Color fundus image · 2352x1568 — 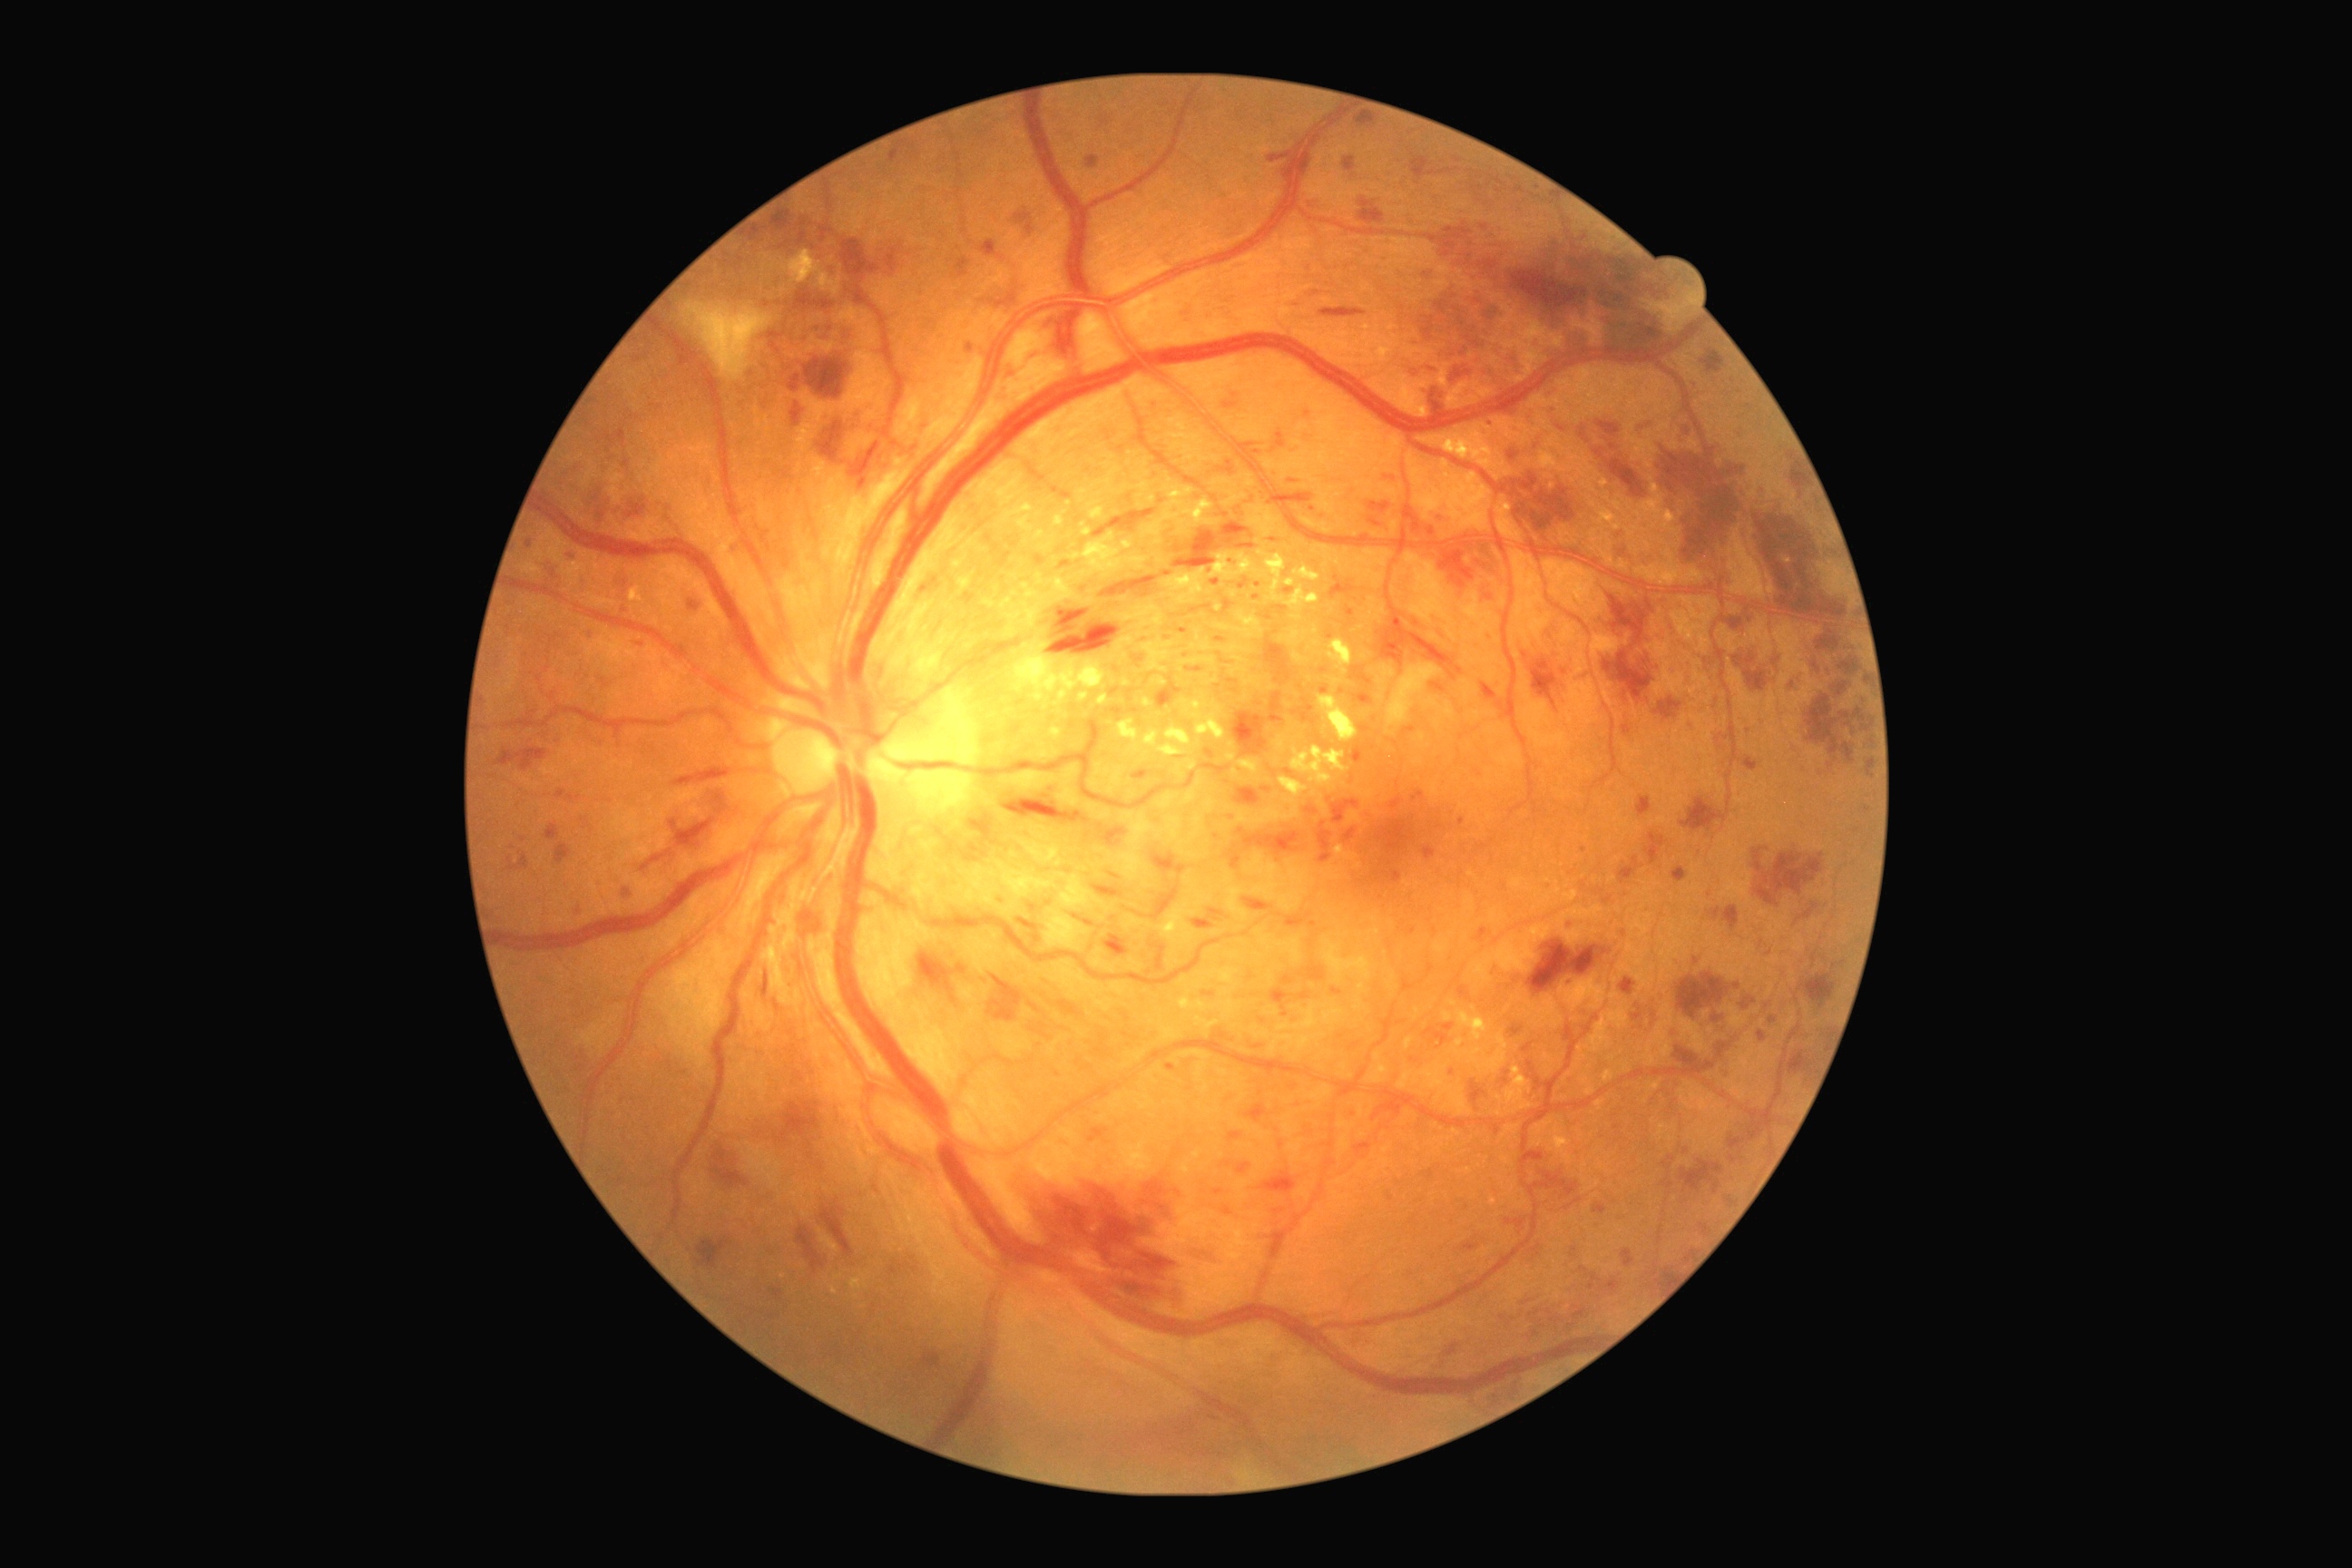

partial: true
dr_grade: 3
dr_grade_name: severe NPDR
lesions:
  ex:
    - x1=1632 y1=476 x2=1683 y2=542
    - x1=1284 y1=585 x2=1320 y2=612
    - x1=1277 y1=736 x2=1284 y2=749
    - x1=1003 y1=502 x2=1034 y2=524
    - x1=1318 y1=801 x2=1328 y2=818
    - x1=1233 y1=656 x2=1250 y2=663
    - x1=1237 y1=1469 x2=1260 y2=1480
    - x1=1122 y1=542 x2=1133 y2=549
    - x1=1164 y1=569 x2=1206 y2=605
    - x1=1208 y1=678 x2=1217 y2=685
    - x1=1415 y1=471 x2=1493 y2=531
    - x1=1237 y1=760 x2=1260 y2=778
  ex_small_approx:
    - [x=1500, y=455]
    - [x=1015, y=594]
    - [x=1070, y=504]
    - [x=1138, y=748]
    - [x=1267, y=703]
  ma:
    - x1=774 y1=1001 x2=779 y2=1012
    - x1=1511 y1=1024 x2=1524 y2=1039
    - x1=1244 y1=1104 x2=1268 y2=1124
    - x1=1112 y1=707 x2=1122 y2=716
    - x1=1030 y1=1004 x2=1039 y2=1012
    - x1=1422 y1=847 x2=1436 y2=861
    - x1=808 y1=1153 x2=814 y2=1161
    - x1=1161 y1=257 x2=1170 y2=270
    - x1=1095 y1=1034 x2=1106 y2=1057
    - x1=1202 y1=992 x2=1217 y2=997
    - x1=689 y1=602 x2=698 y2=611
    - x1=1035 y1=554 x2=1046 y2=567
    - x1=1422 y1=1166 x2=1442 y2=1182
  ma_small_approx:
    - [x=1605, y=953]
    - [x=1622, y=553]
    - [x=1749, y=407]
    - [x=624, y=611]
    - [x=1155, y=408]
    - [x=1561, y=429]
  he:
    - x1=1787 y1=678 x2=1803 y2=692
    - x1=1596 y1=422 x2=1620 y2=436
    - x1=1331 y1=799 x2=1360 y2=825
    - x1=1320 y1=309 x2=1367 y2=318
    - x1=1841 y1=712 x2=1850 y2=720
    - x1=1369 y1=518 x2=1382 y2=527
    - x1=1792 y1=467 x2=1805 y2=489
    - x1=1193 y1=908 x2=1224 y2=930
    - x1=1101 y1=576 x2=1157 y2=598
    - x1=1788 y1=1052 x2=1810 y2=1075
    - x1=1678 y1=974 x2=1730 y2=1019
    - x1=1237 y1=828 x2=1300 y2=856
    - x1=1373 y1=1088 x2=1467 y2=1130
    - x1=1749 y1=502 x2=1828 y2=603
    - x1=696 y1=1239 x2=732 y2=1268
    - x1=1680 y1=1161 x2=1723 y2=1193
    - x1=642 y1=856 x2=665 y2=872
  he_small_approx:
    - [x=1733, y=1159]